Infant wide-field retinal image. 100° field of view (Phoenix ICON)
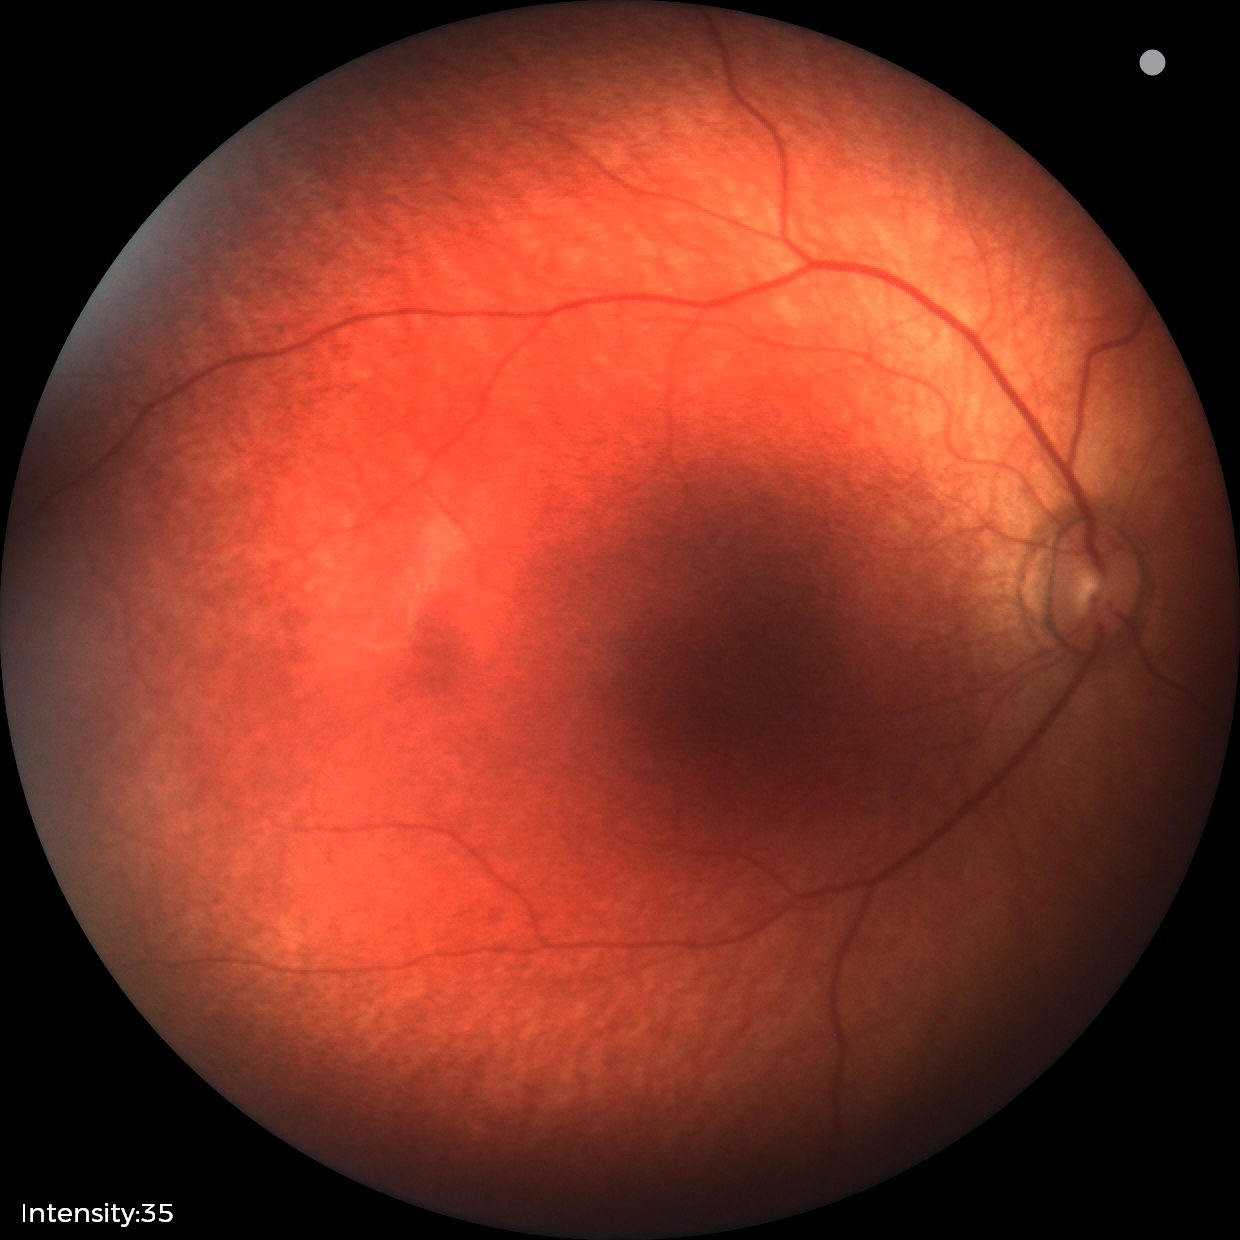
No retinal pathology identified on screening.